Color fundus image:
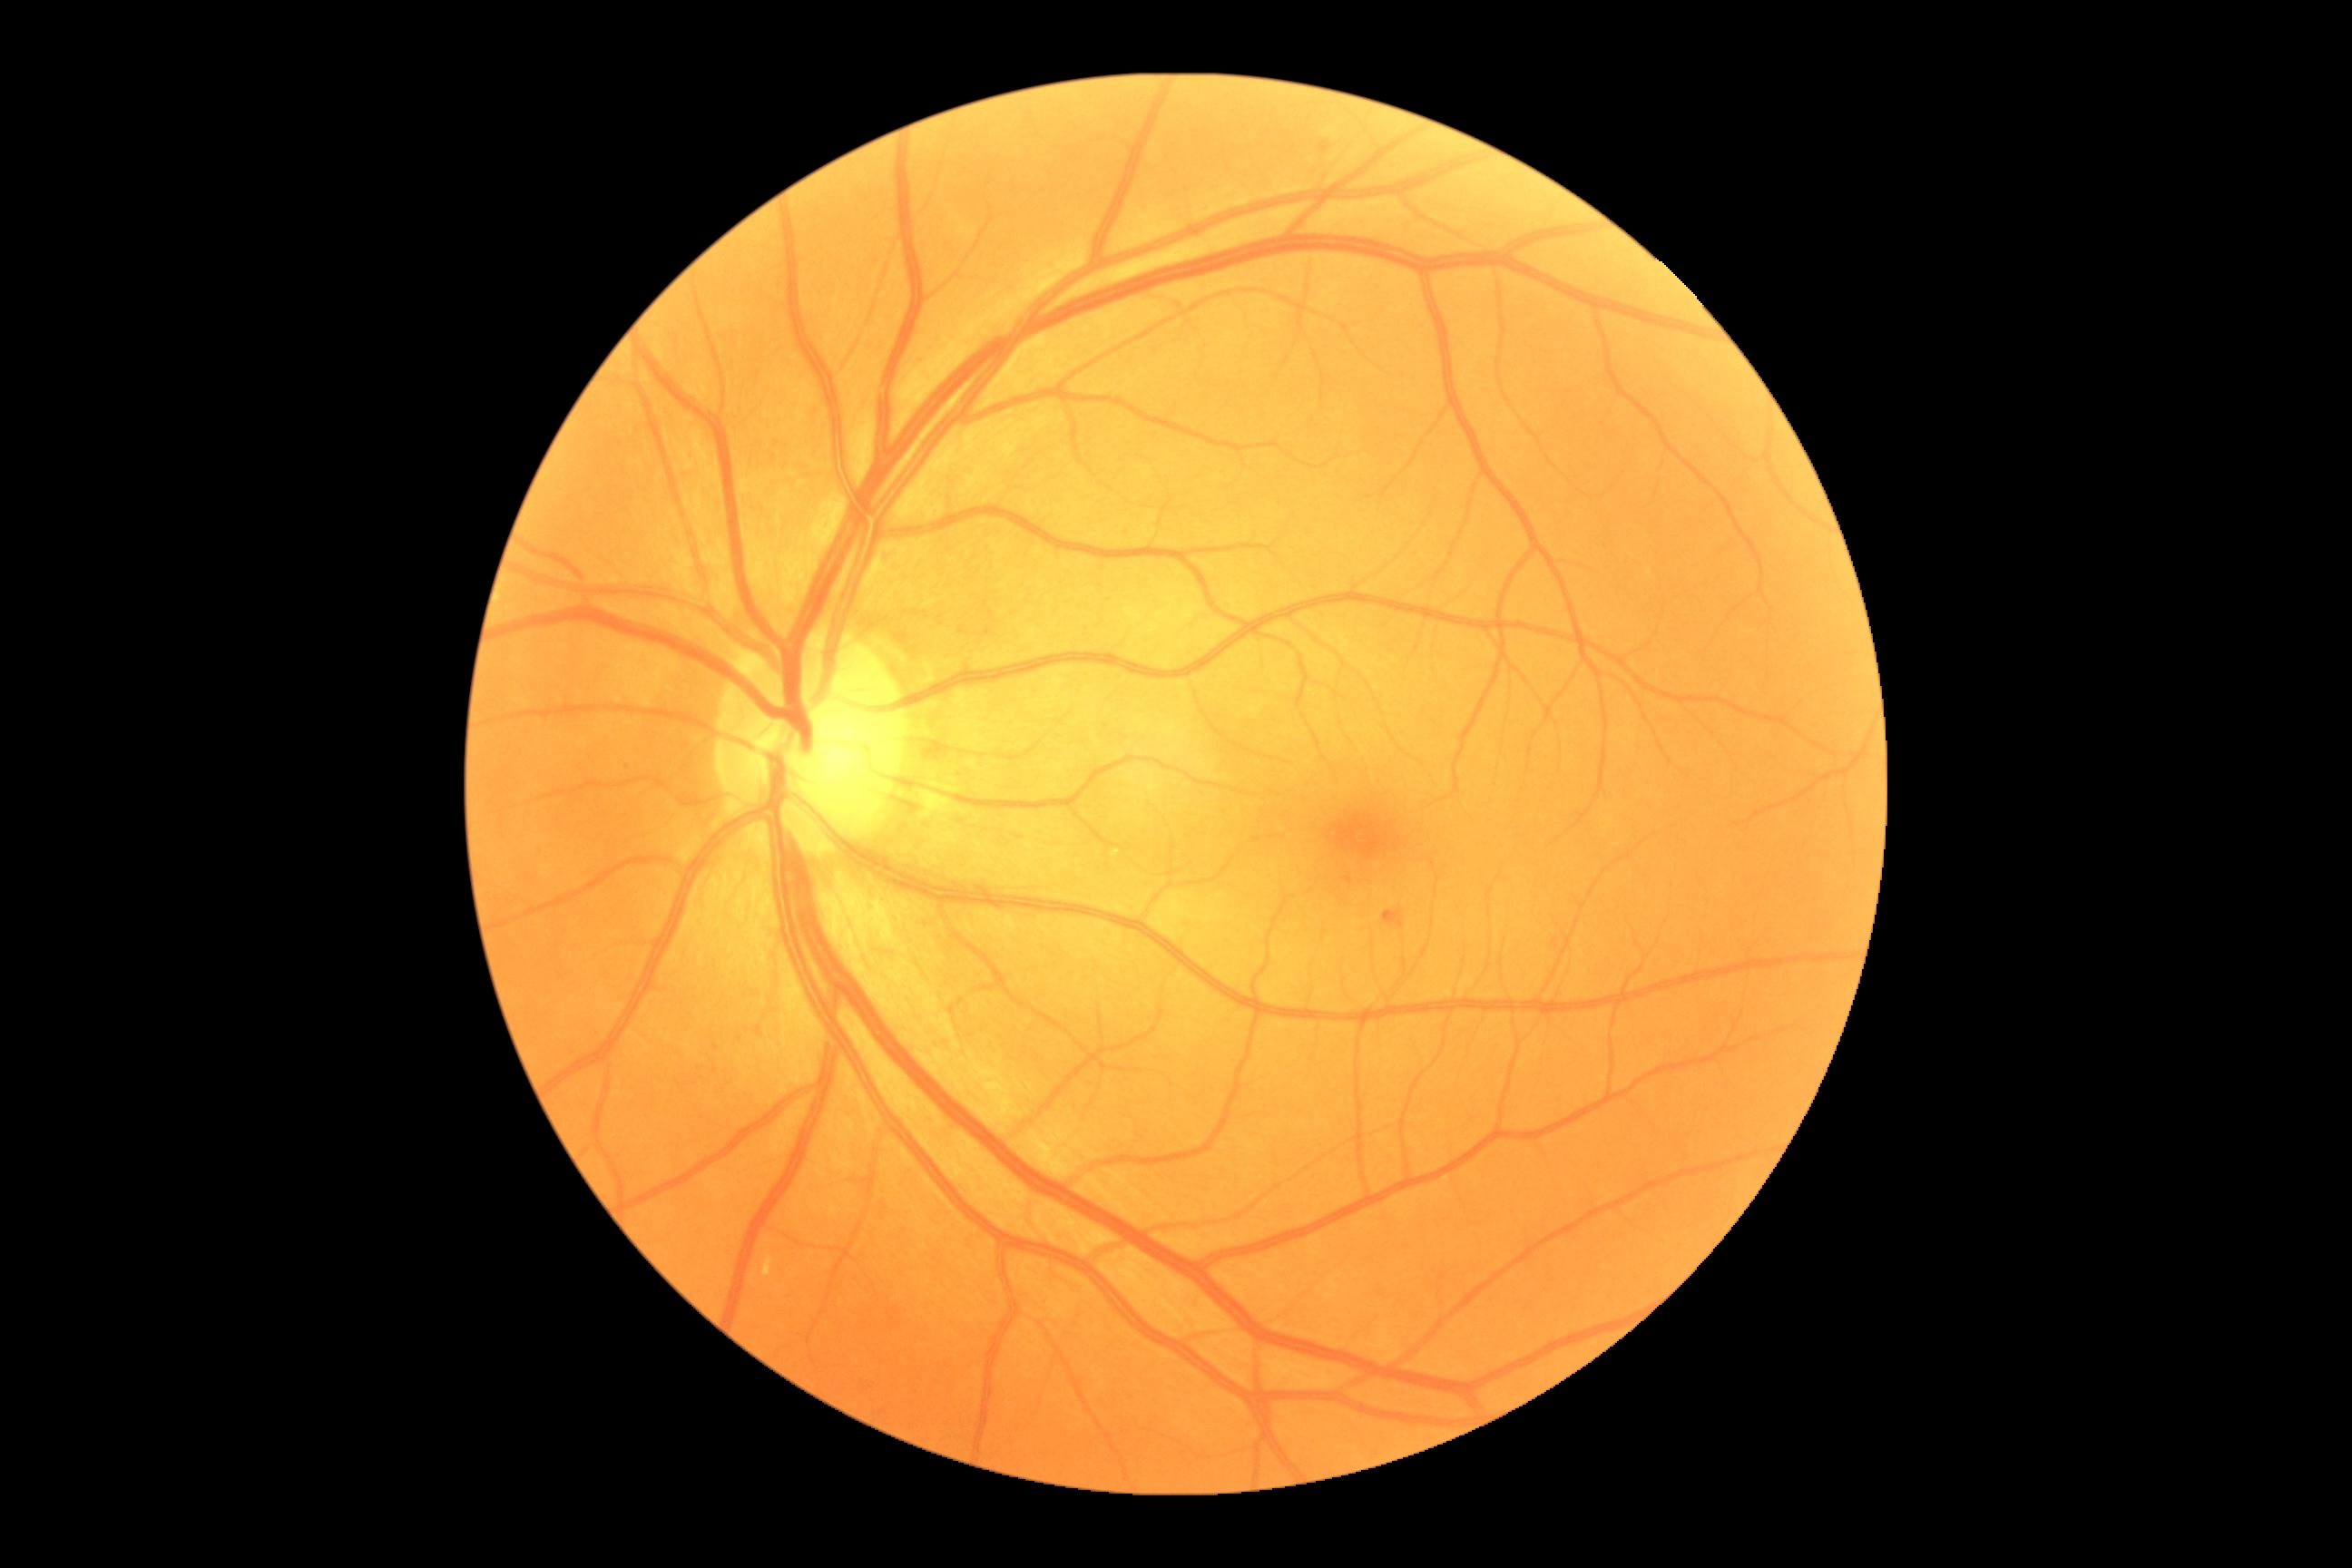 retinopathy grade = 2